Infant wide-field retinal image:
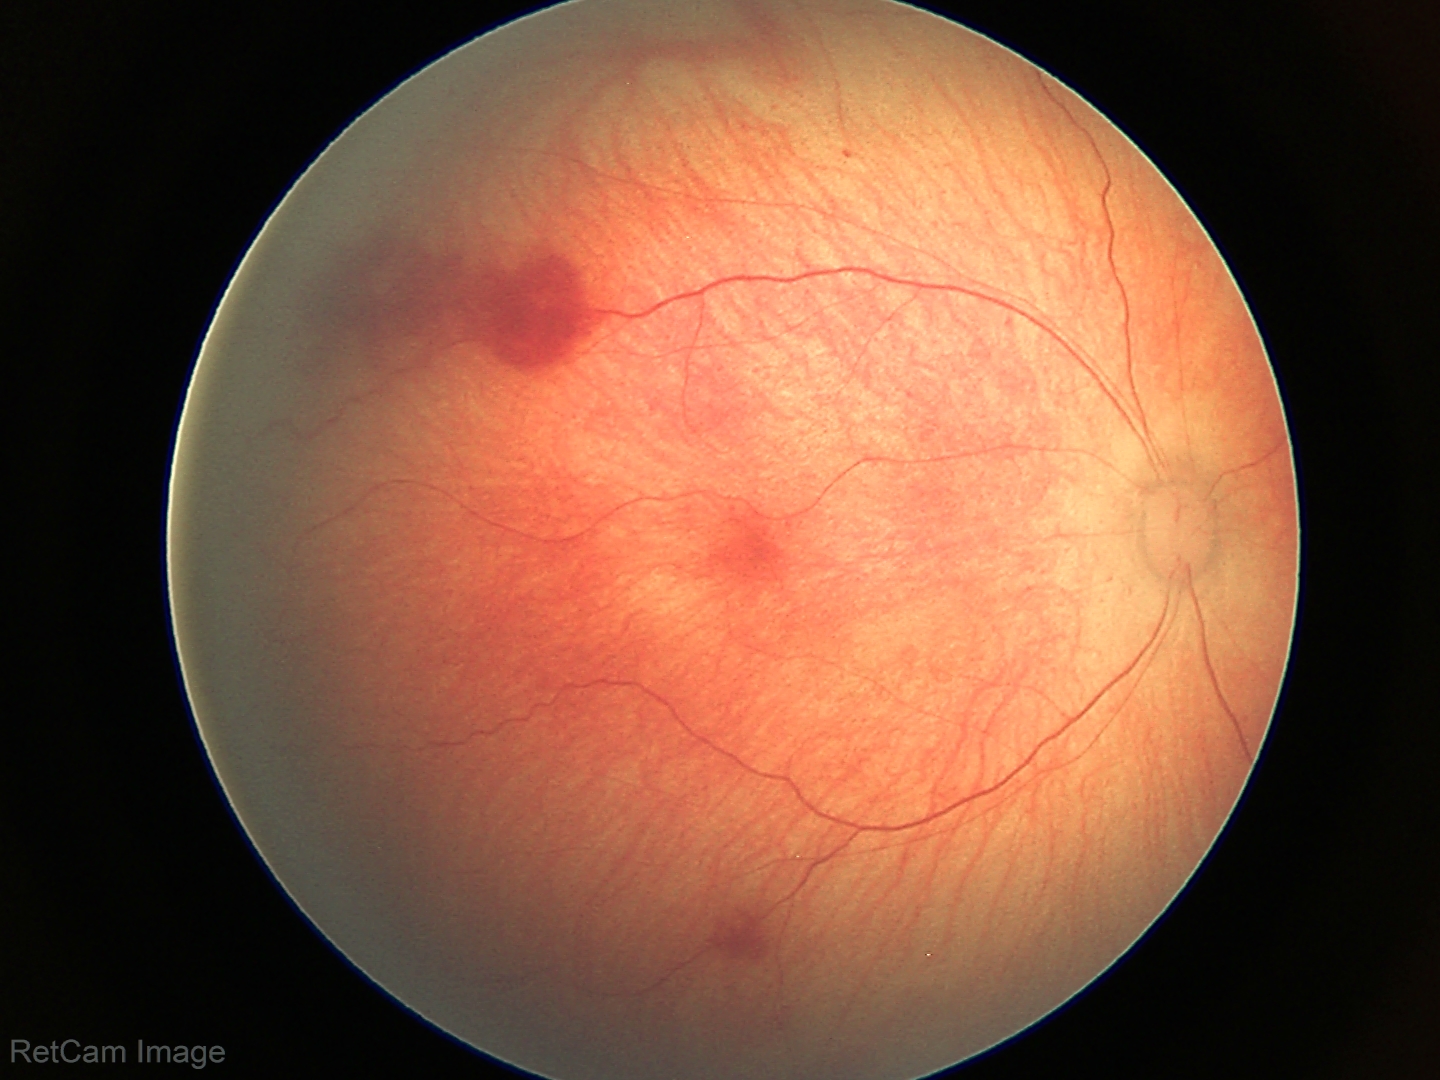 Screening diagnosis: retinal hemorrhages.